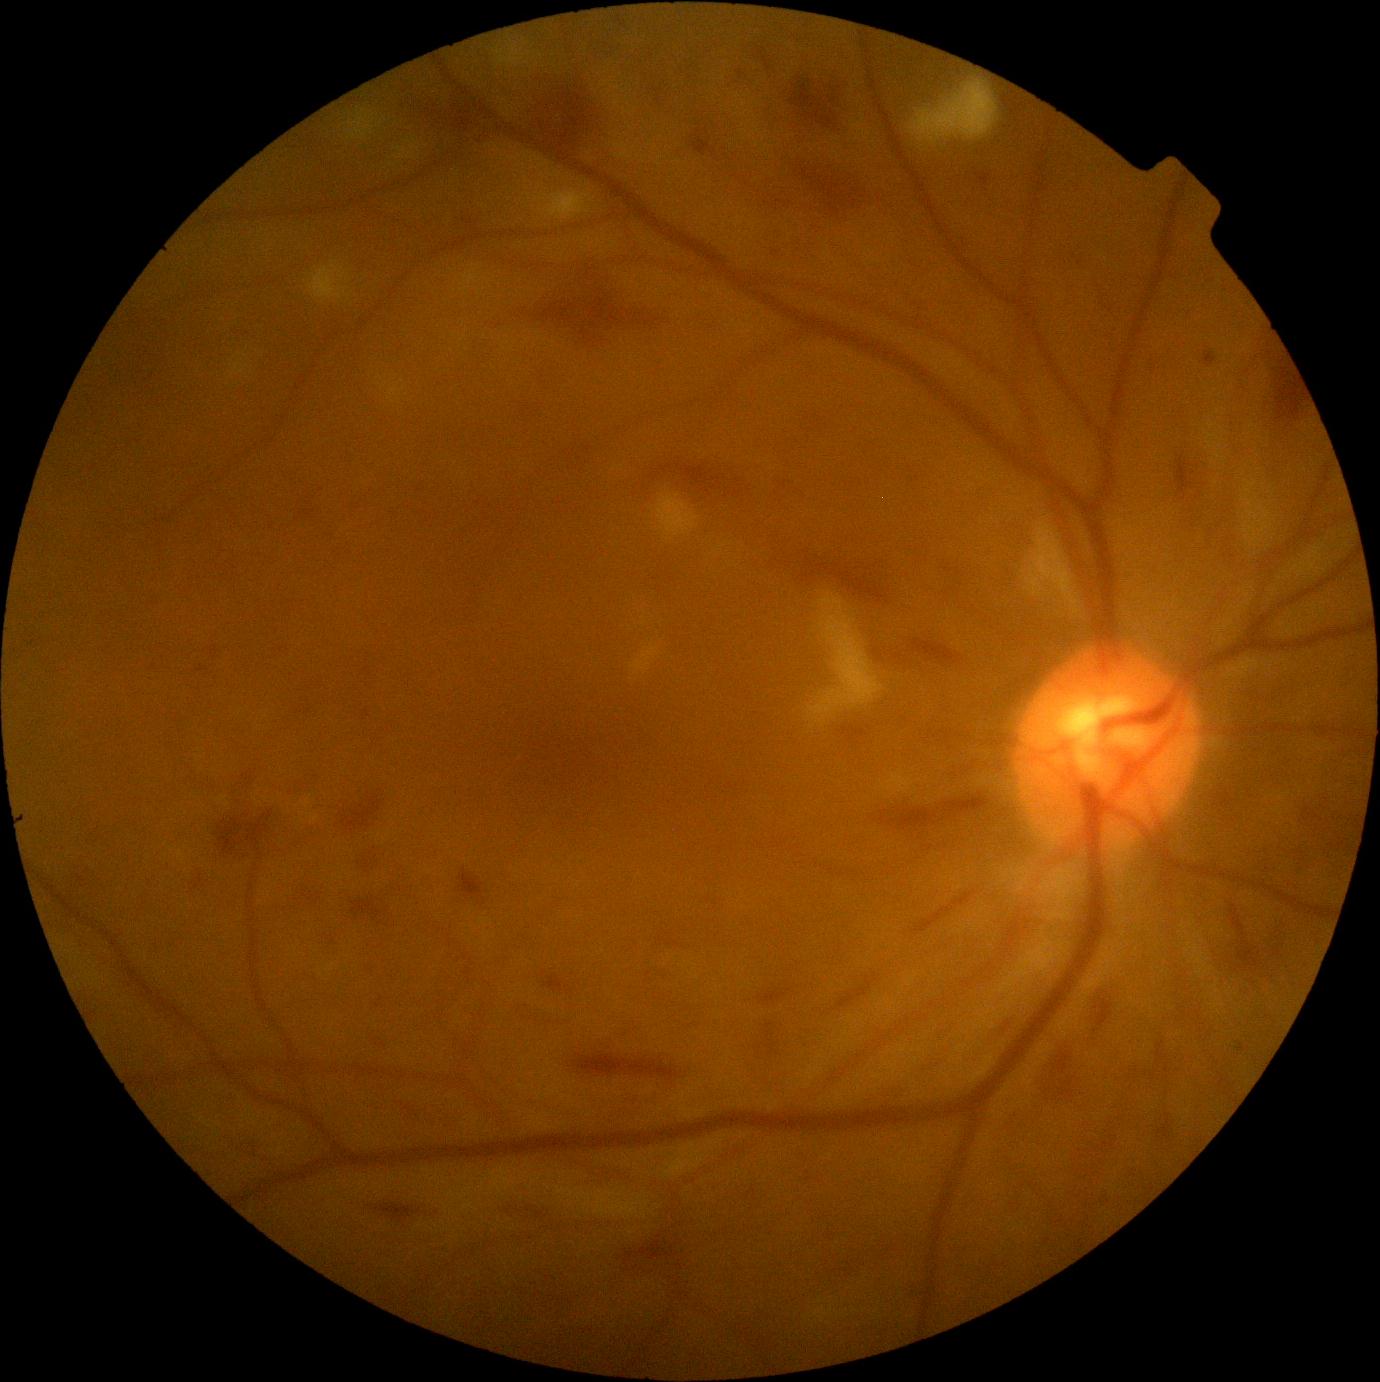
DR is 3.